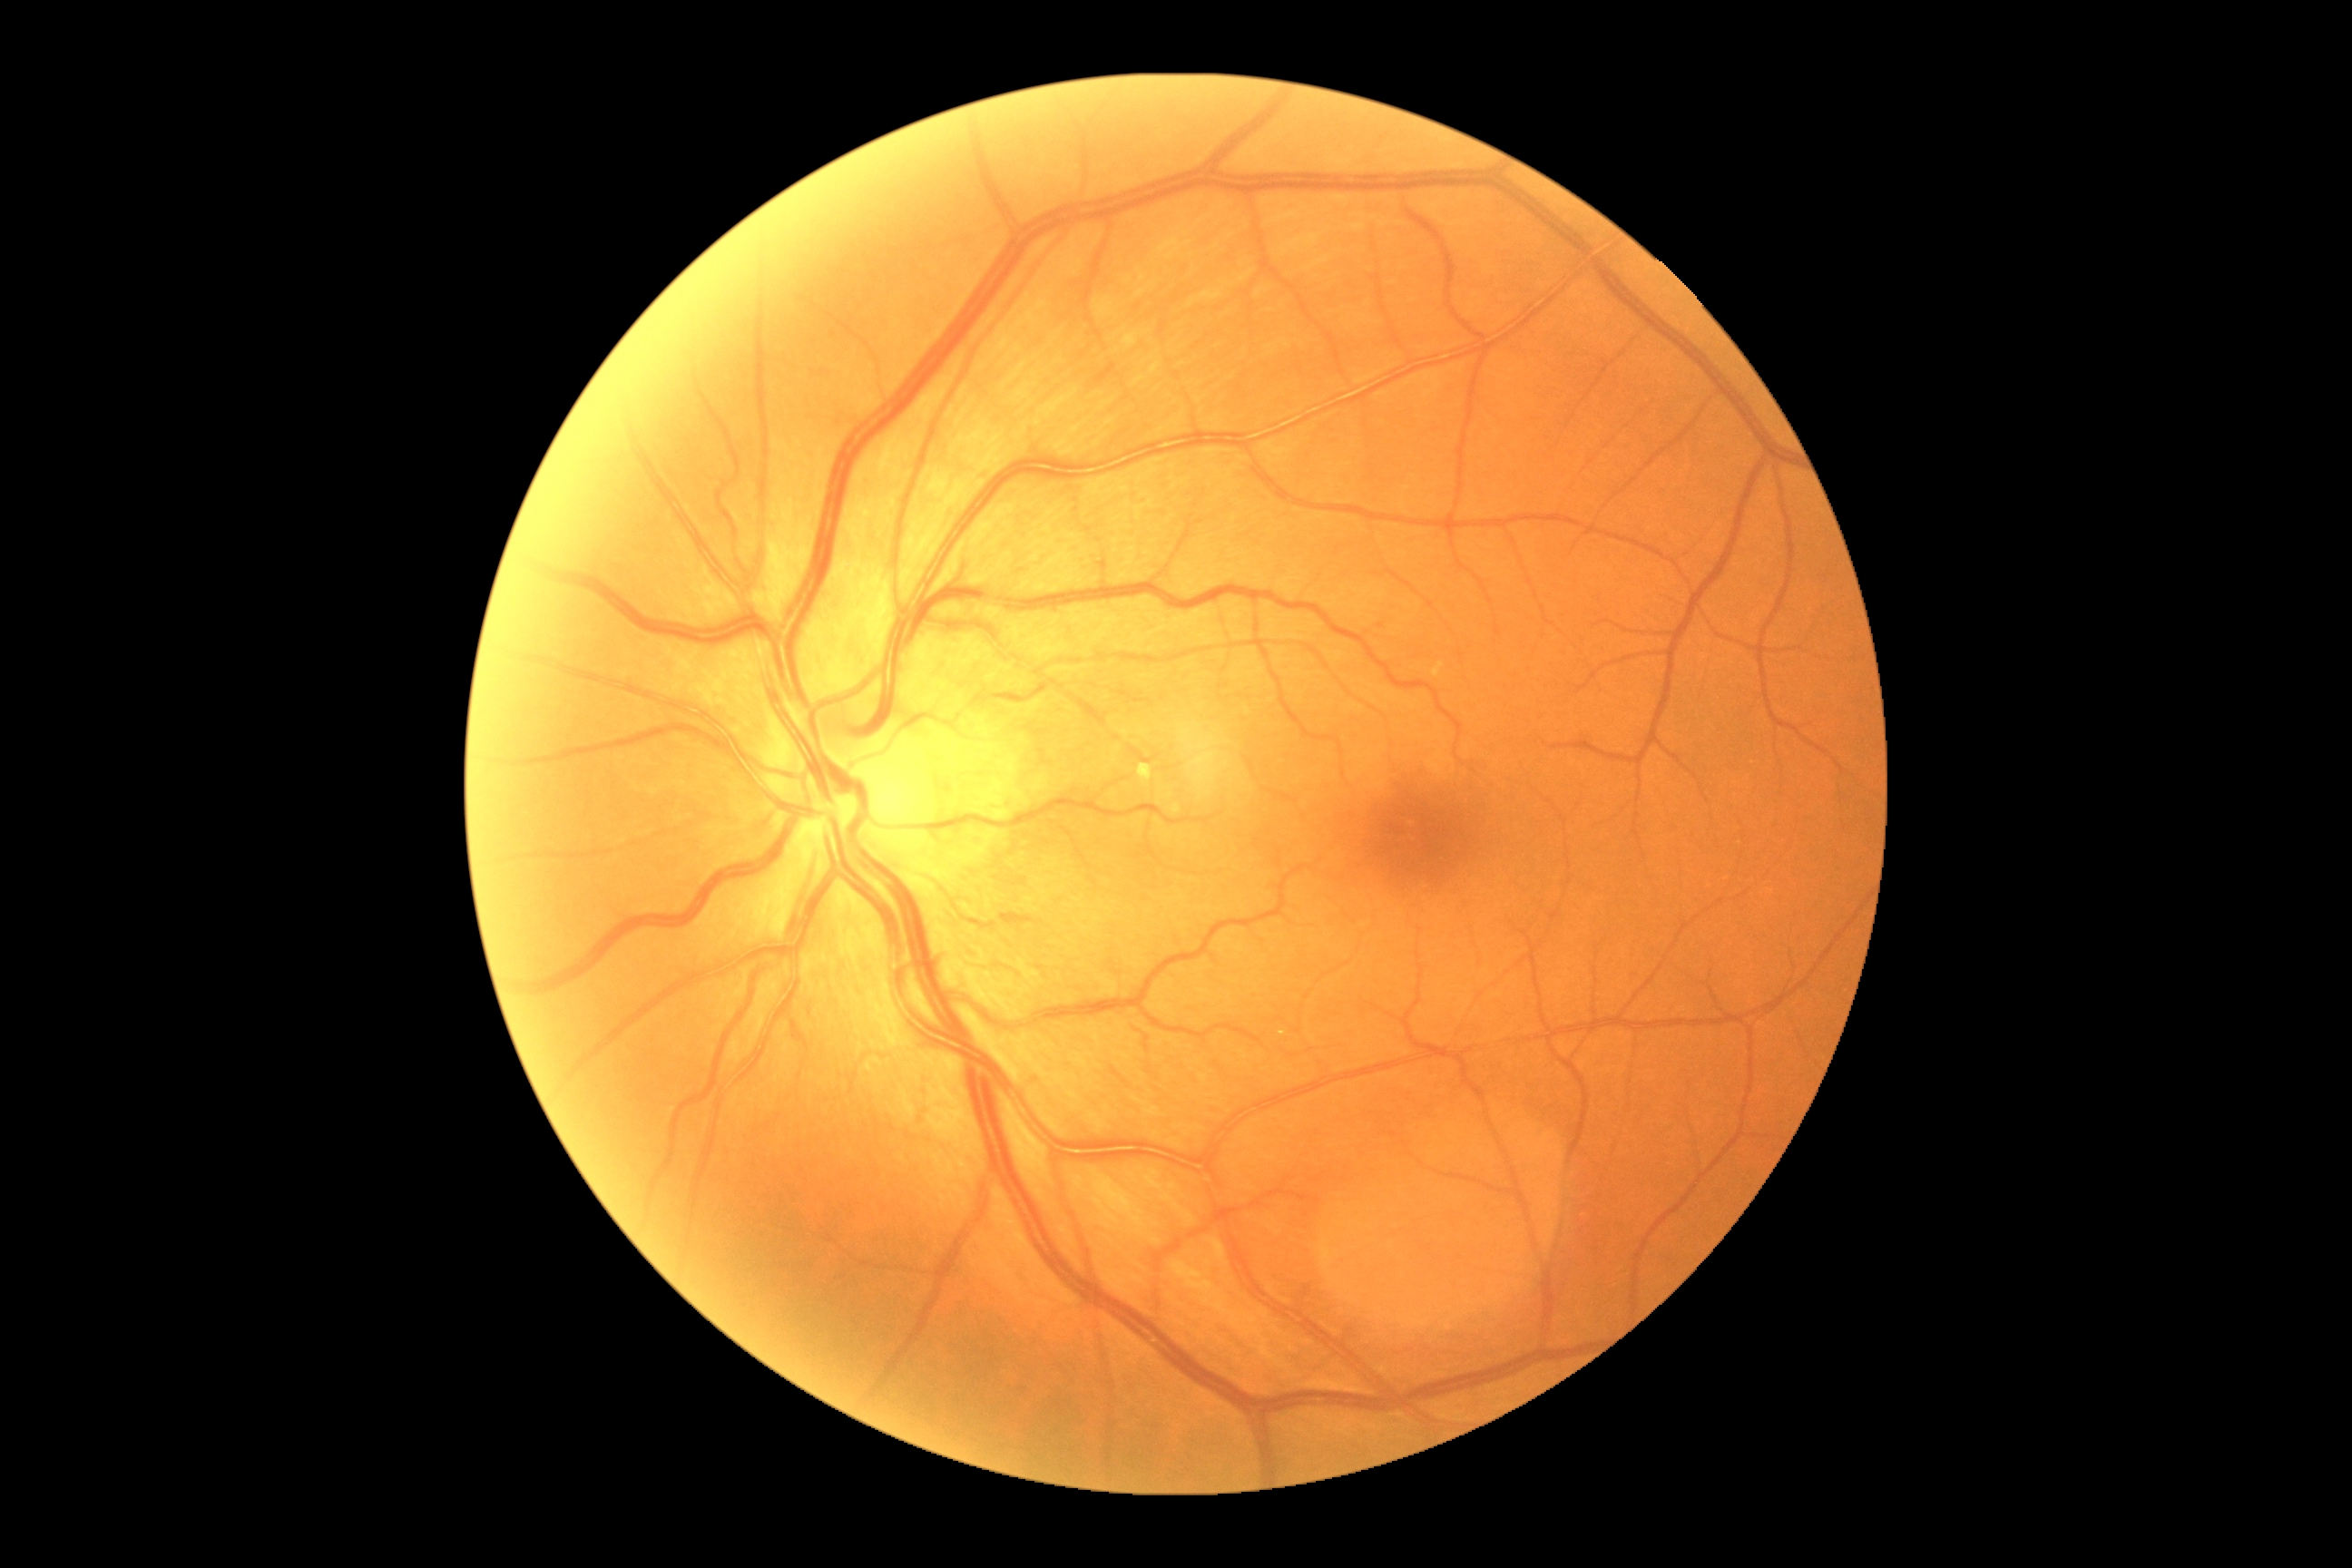

Diabetic retinopathy is 0.